FOV: 45 degrees, color fundus photograph: 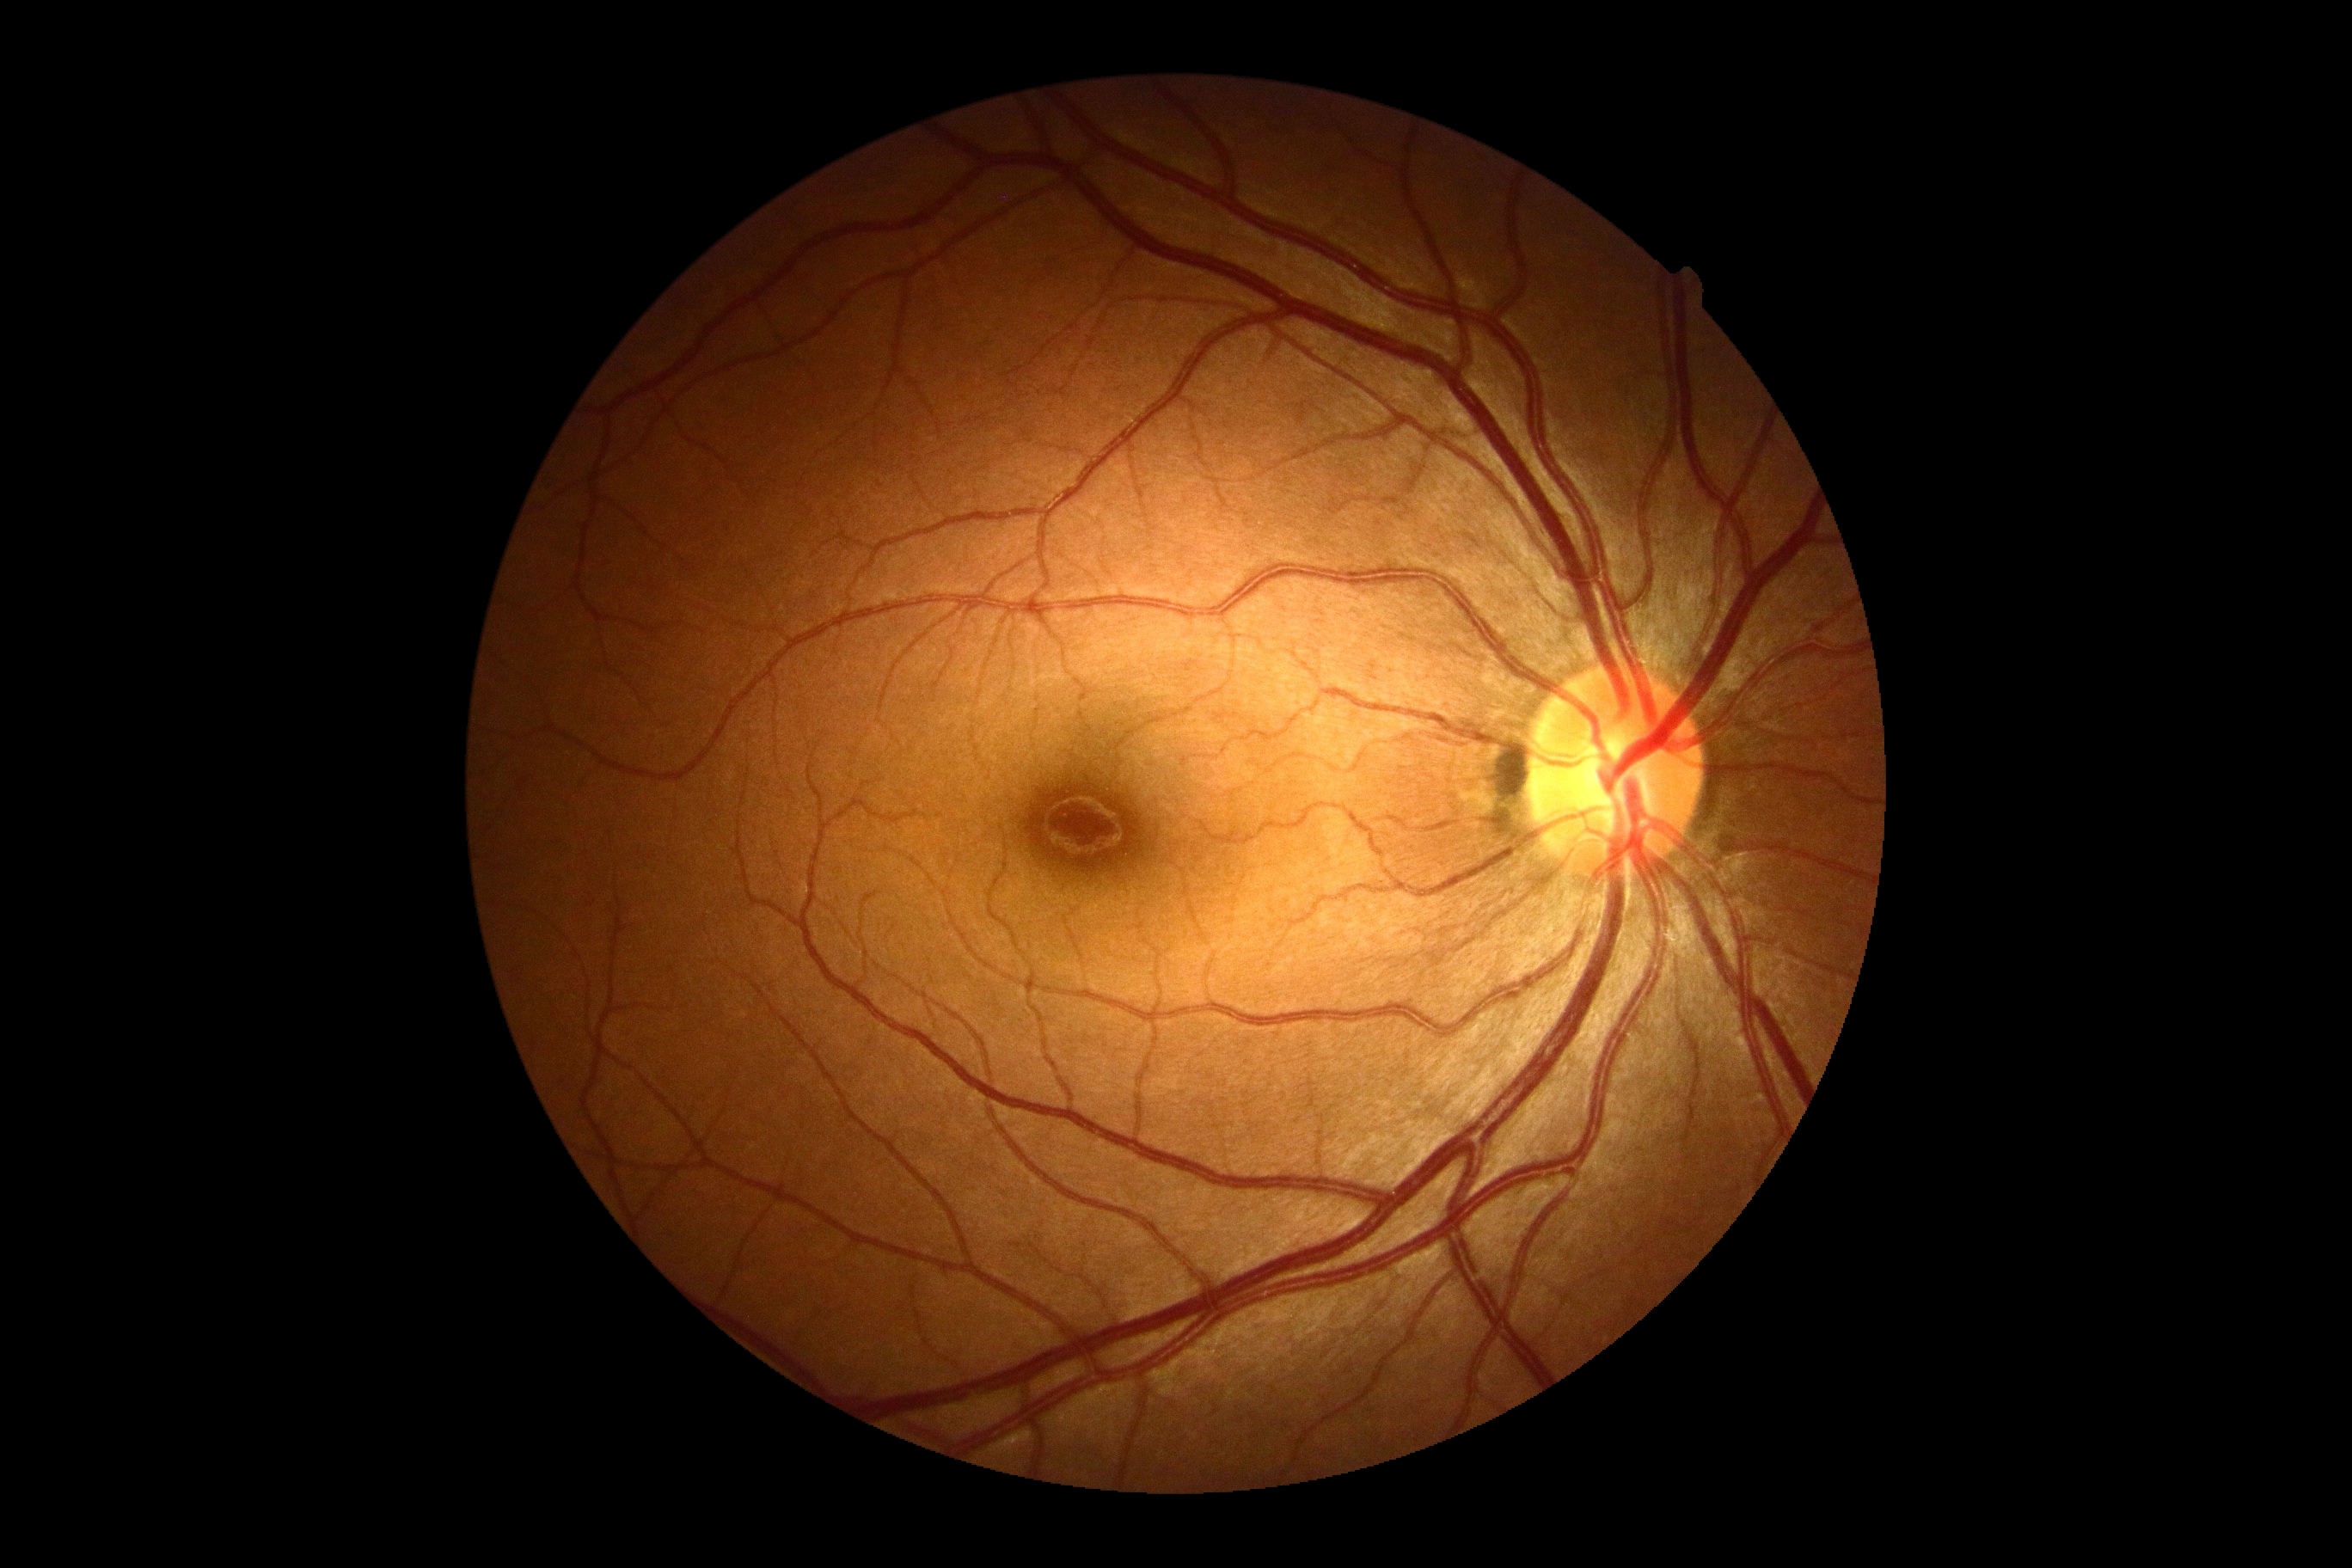
retinopathy = 0, DR impression = no apparent DR.